1932x1932px · 50-degree field of view — 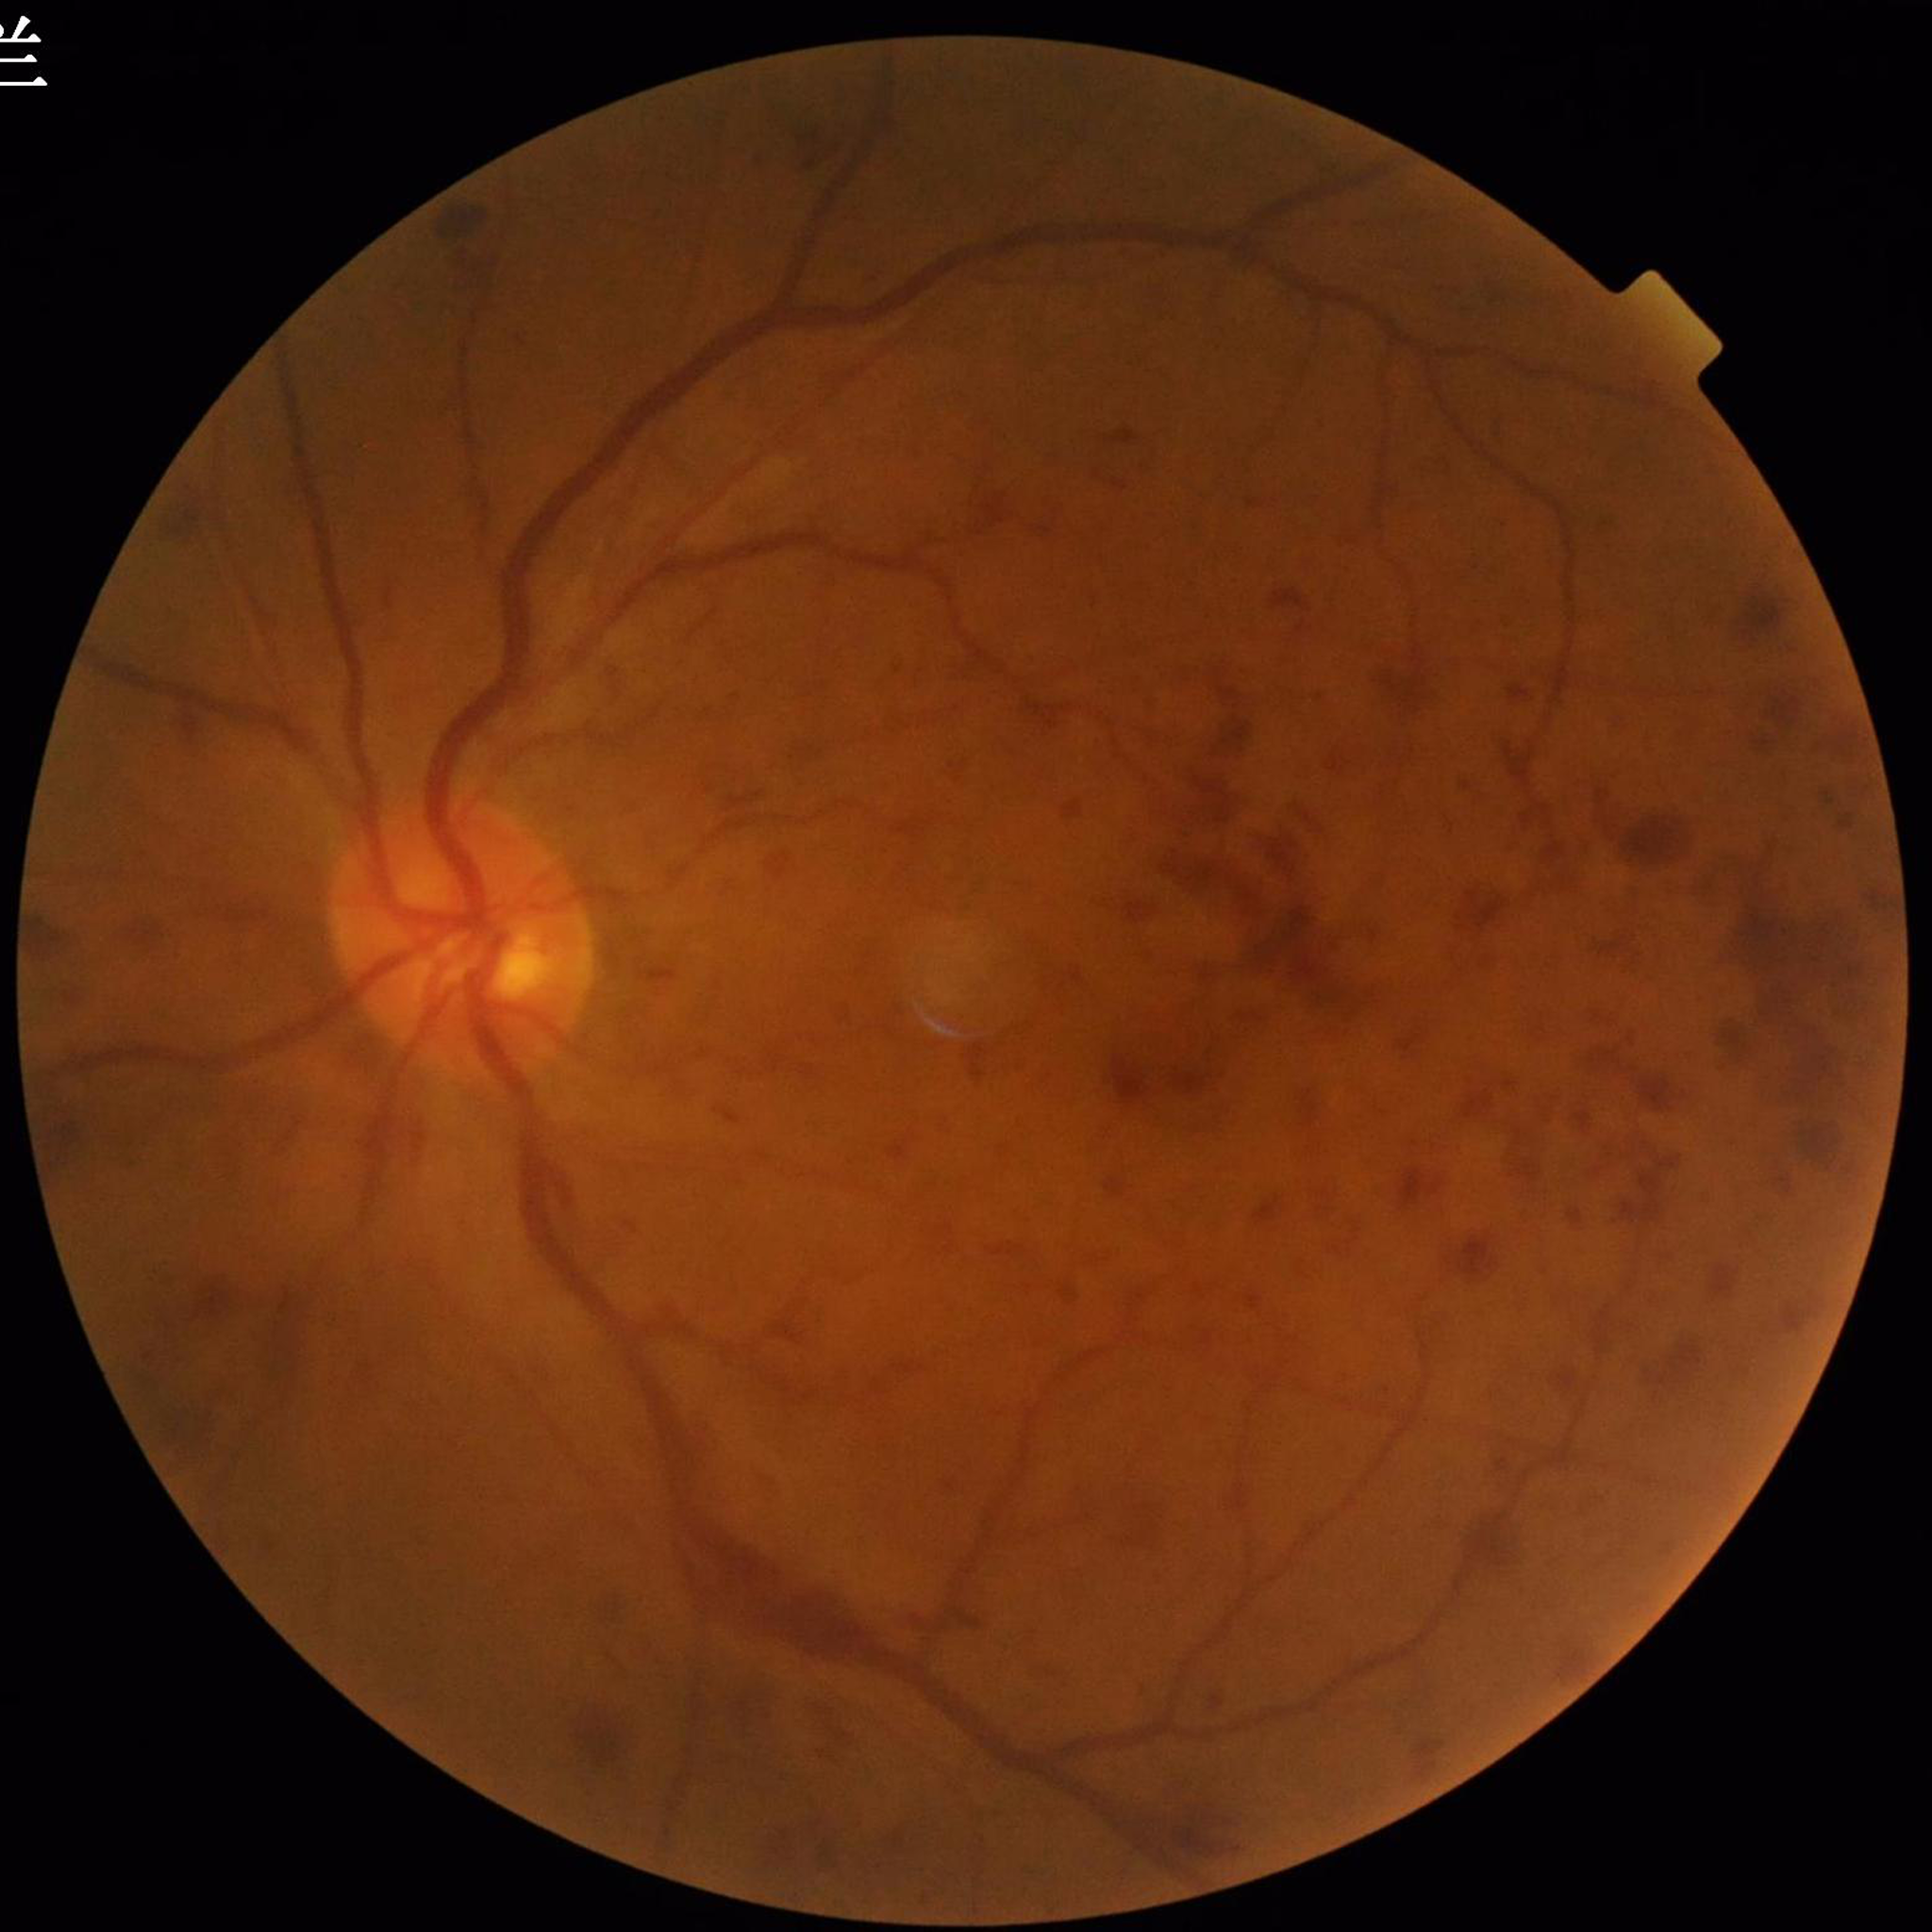
This fundus photograph is from a patient diagnosed with diabetic retinopathy. Photo quality: no blur, illumination and color satisfactory, contrast adequate.